FOV: 45 degrees; CFP:
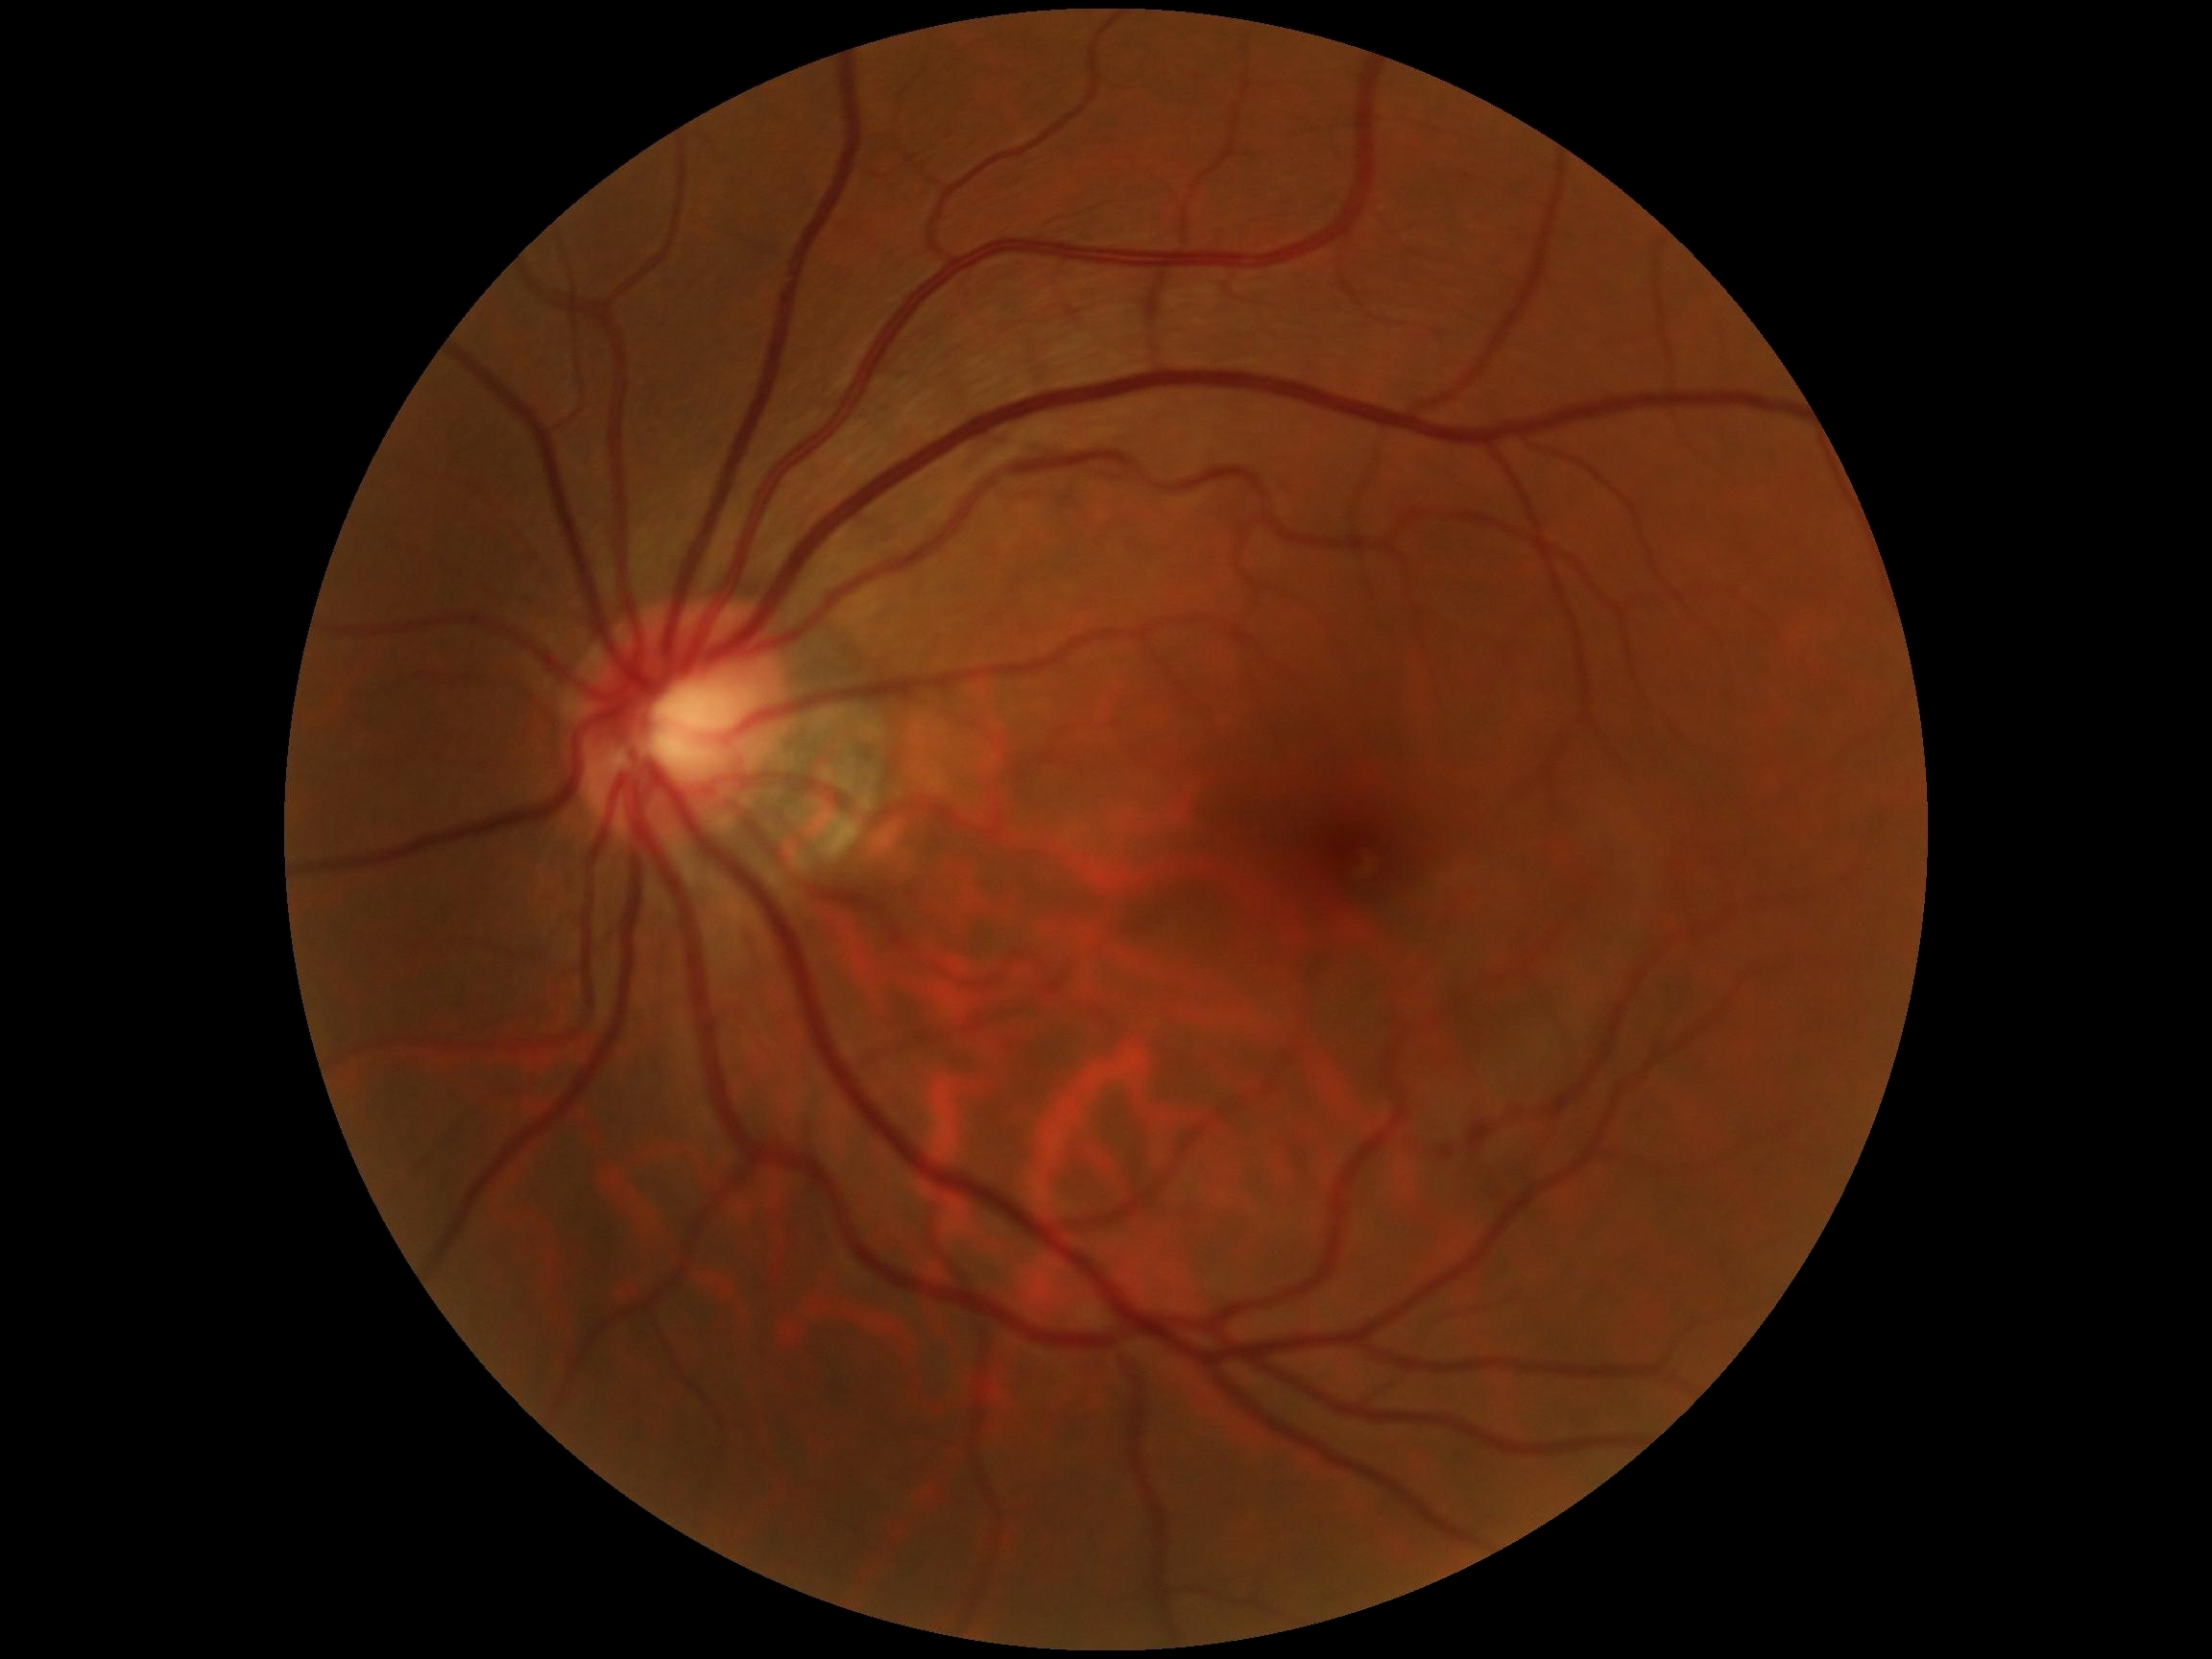
* retinopathy grade: 0/4